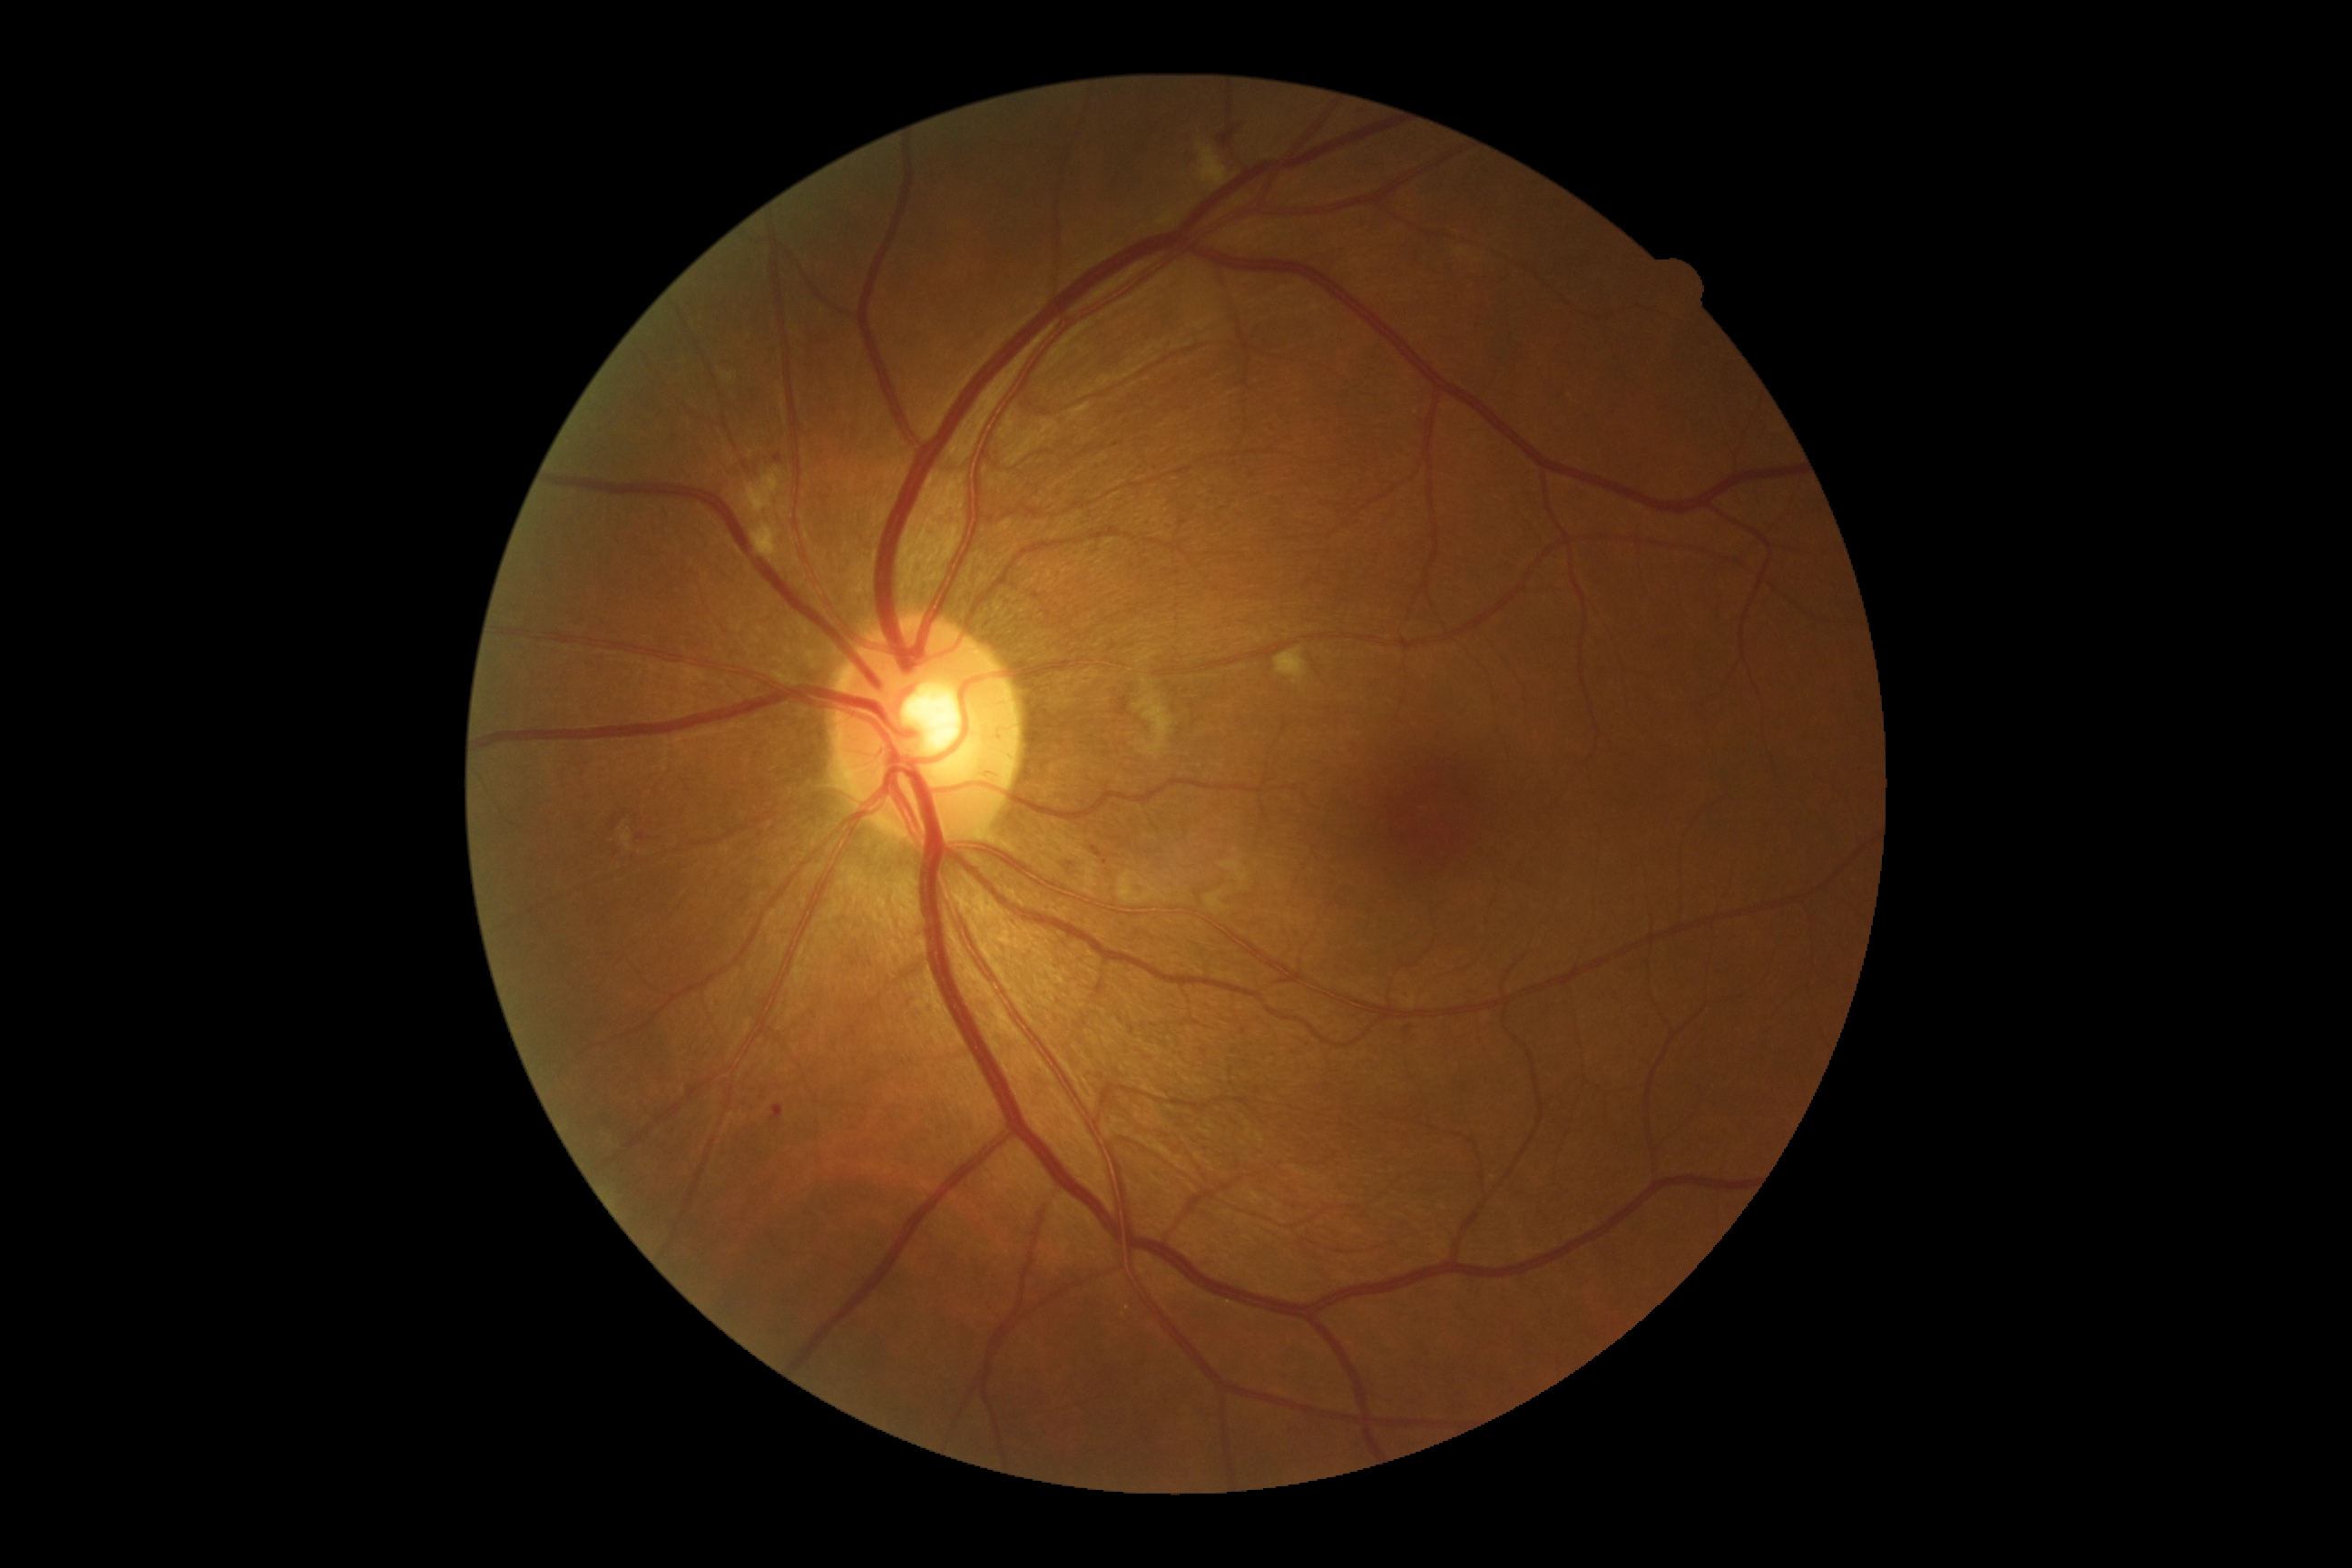

<lesions partial="true">
  <dr_grade>2</dr_grade>
  <ex />
  <ma partial="true">Rect(774, 455, 783, 464) | Rect(770, 1104, 785, 1122) | Rect(636, 834, 645, 841) | Rect(1095, 850, 1104, 858) | Rect(928, 1006, 934, 1014)</ma>
  <ma_small><point>1105, 862</point></ma_small>
  <se>Rect(1197, 144, 1231, 186) | Rect(1119, 872, 1168, 906) | Rect(752, 522, 779, 564) | Rect(1275, 647, 1308, 685) | Rect(1137, 692, 1173, 761) | Rect(1083, 861, 1101, 897) | Rect(1456, 250, 1467, 257) | Rect(618, 816, 634, 848) | Rect(743, 467, 783, 516) | Rect(1200, 863, 1255, 906) | Rect(721, 369, 741, 400)</se>
  <he>Rect(1220, 121, 1246, 144) | Rect(1181, 152, 1191, 162)</he>
</lesions>